Wide-field contact fundus photograph of an infant; captured with the Natus RetCam Envision (130° field of view).
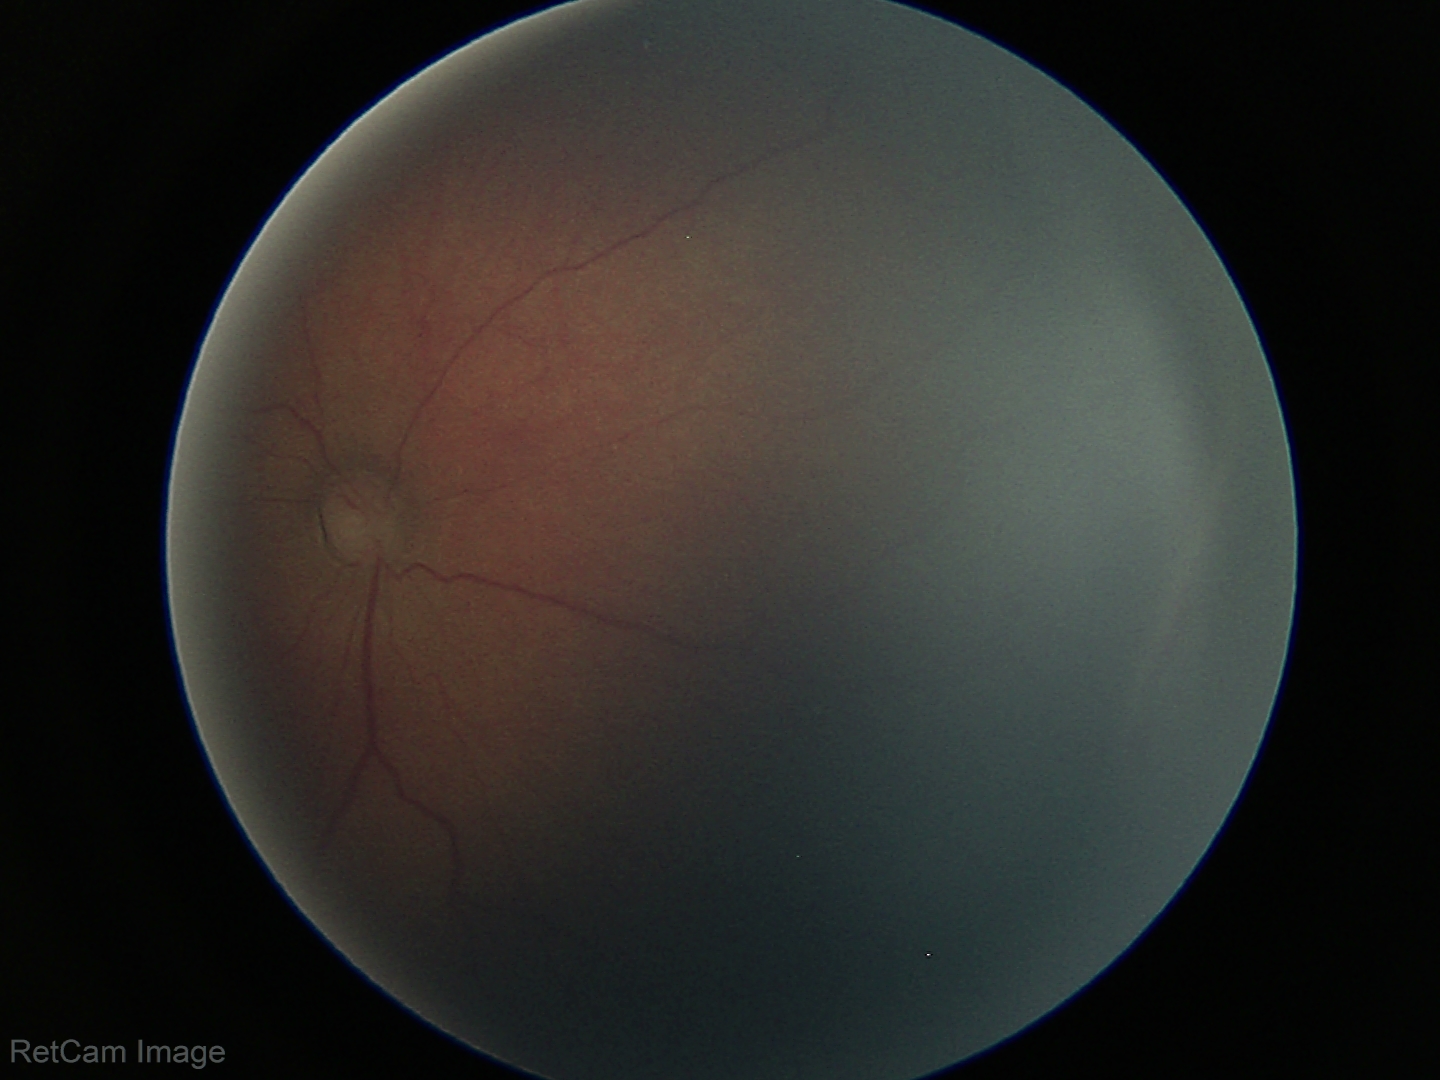

No plus disease. From an examination with diagnosis of retinopathy of prematurity stage 2 — ridge with height and width at the demarcation line.